Dilated-pupil acquisition. Posterior pole field covering the optic disc and macula: 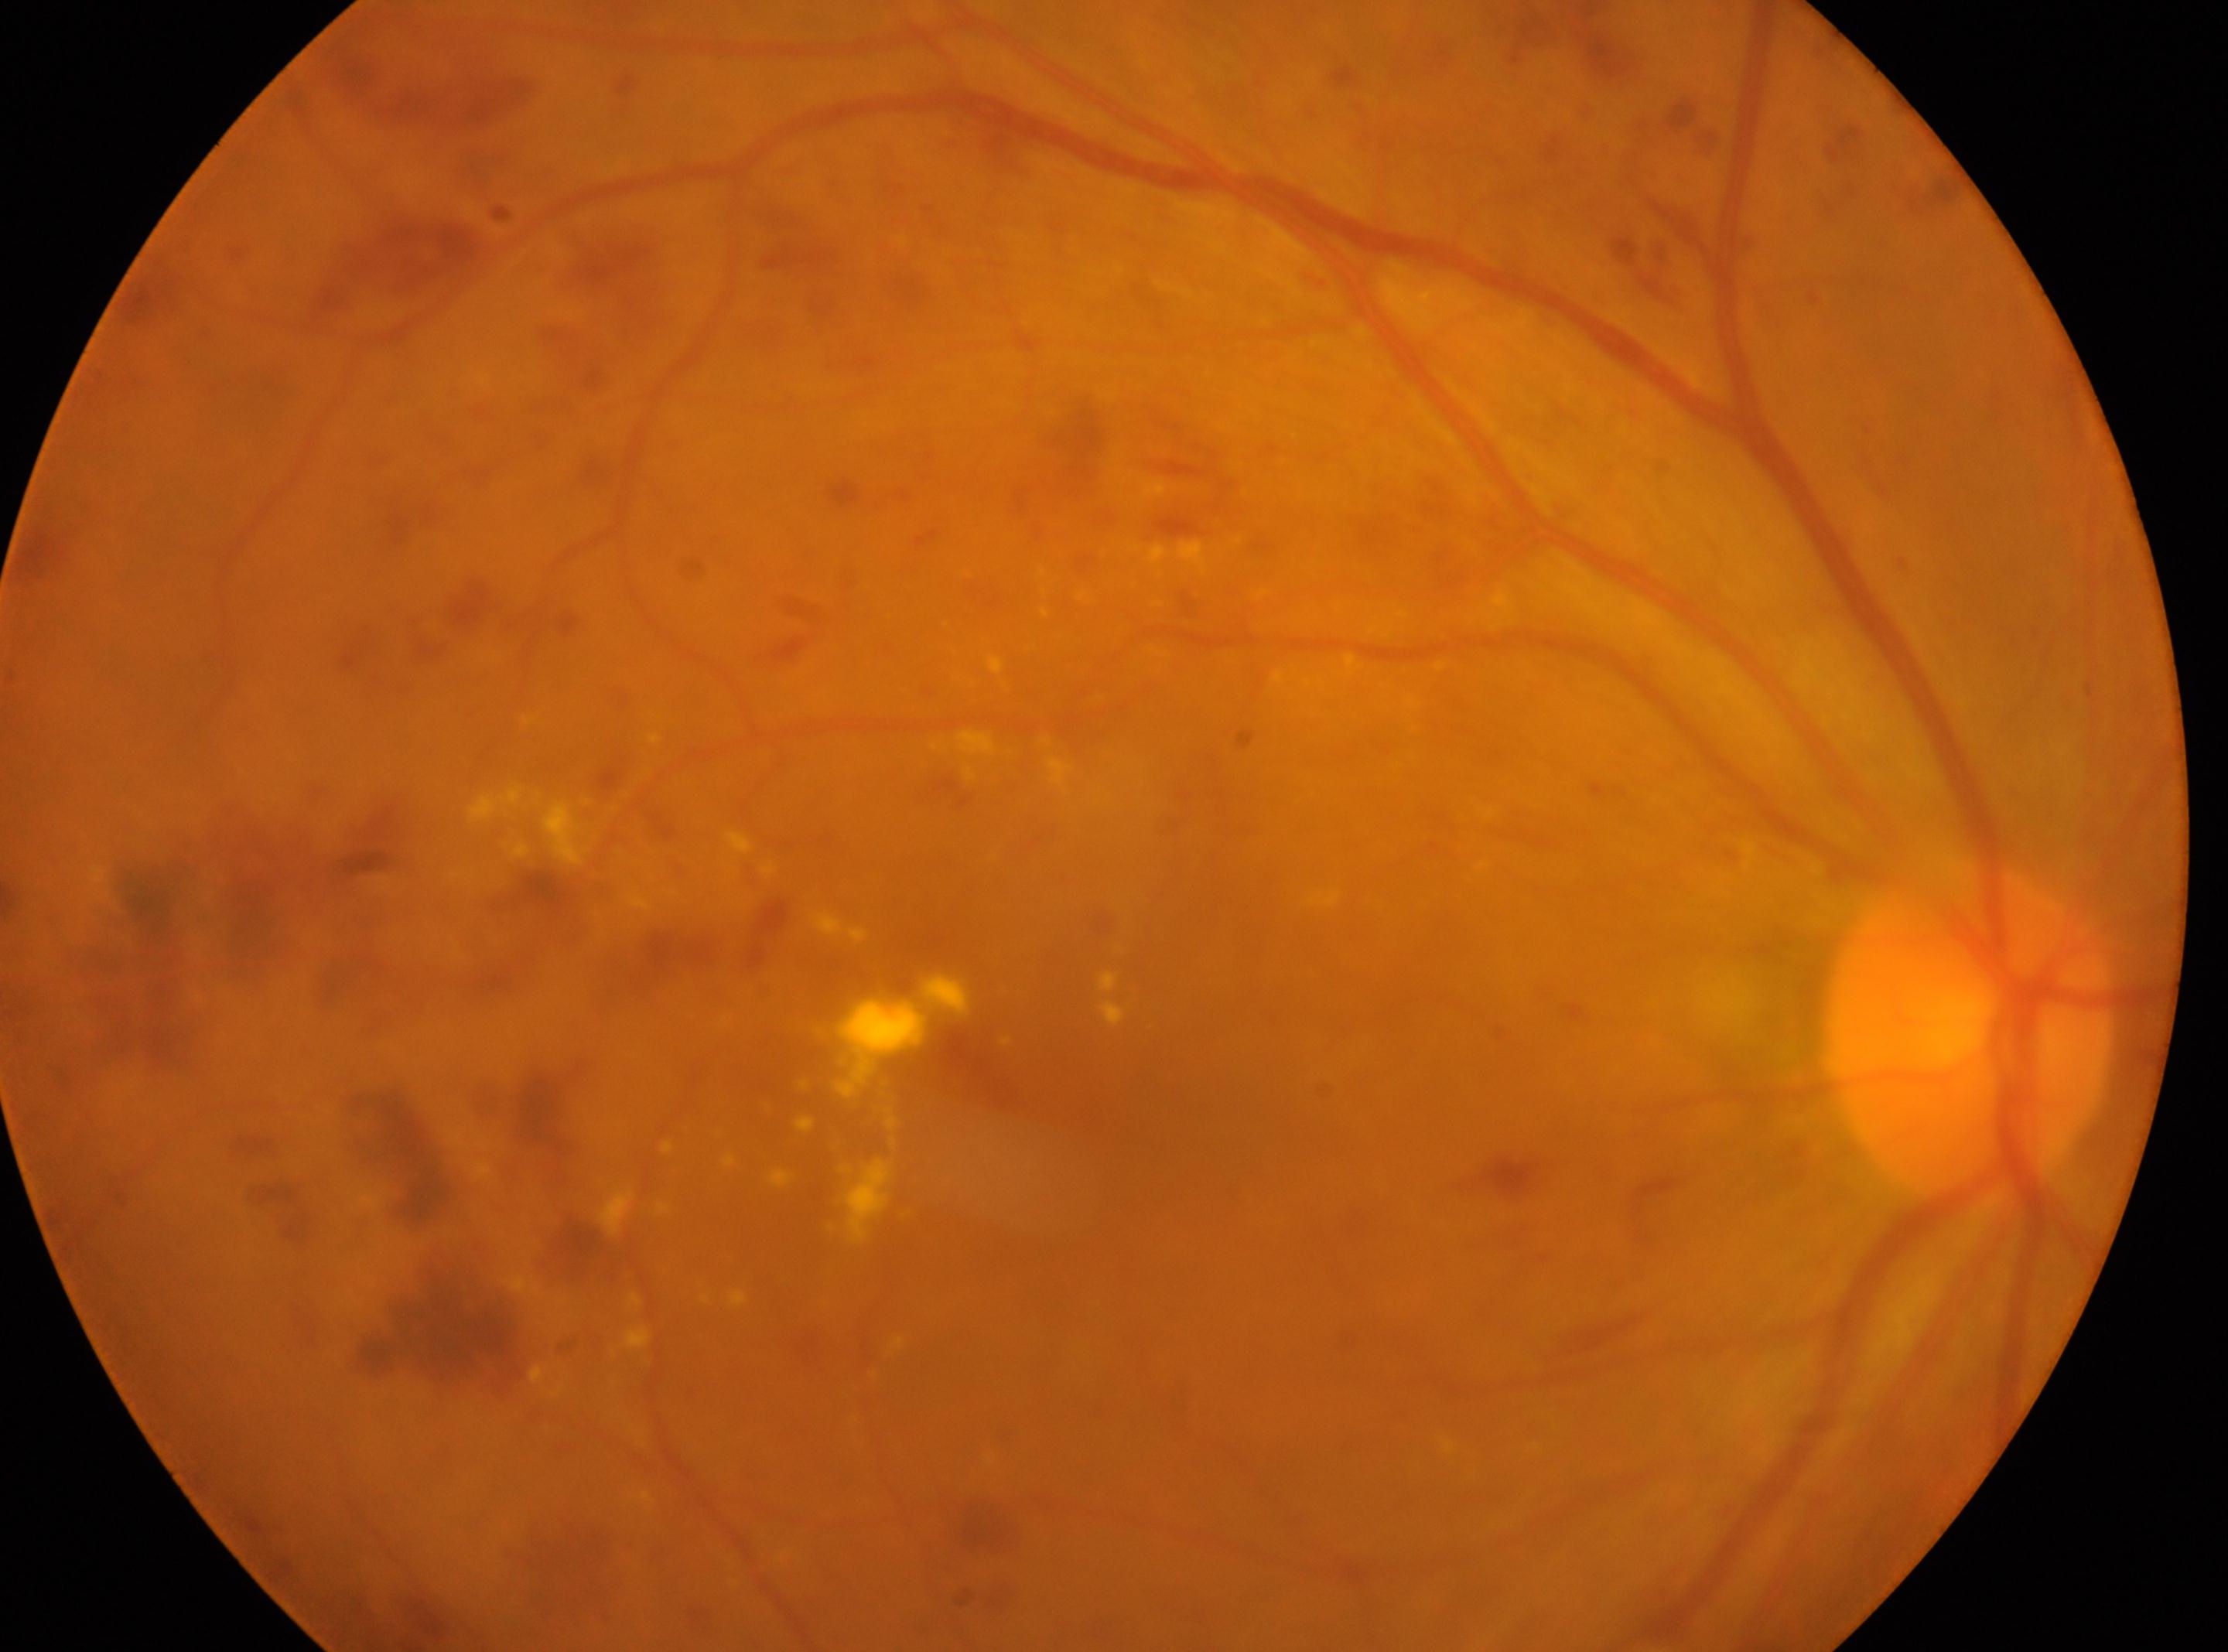
{"dr_grade": "3", "fovea": "(x: 1188, y: 1083)", "eye": "right eye", "optic_disc": "(x: 1967, y: 1032)"}